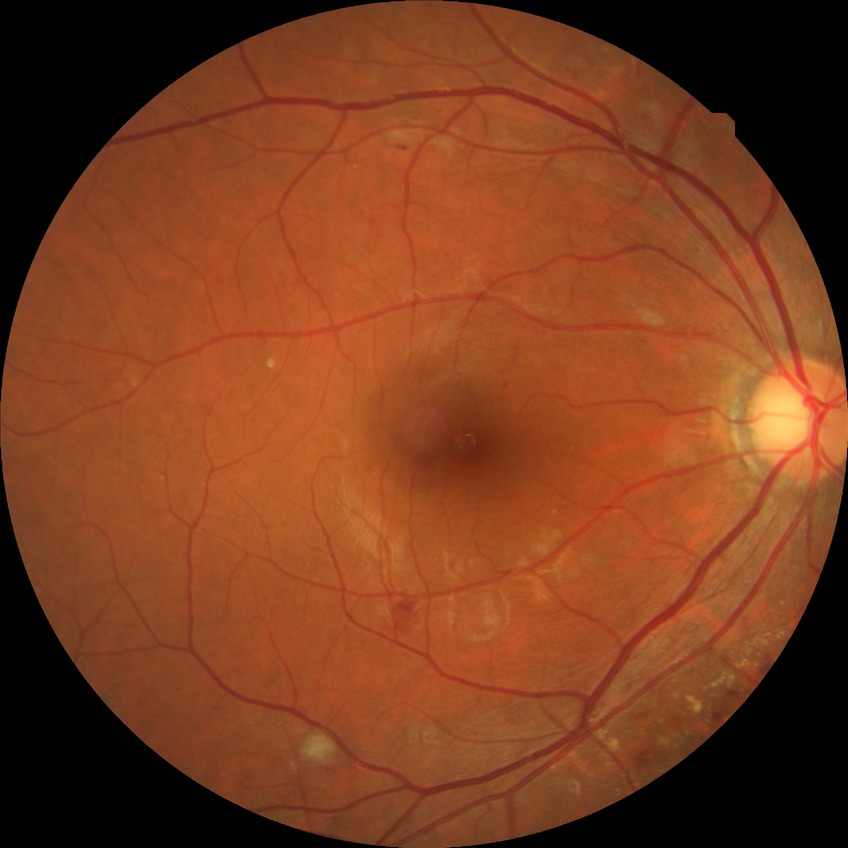
DR class: non-proliferative diabetic retinopathy.
Diabetic retinopathy (DR): simple diabetic retinopathy (SDR).